Color fundus image, FOV: 45 degrees — 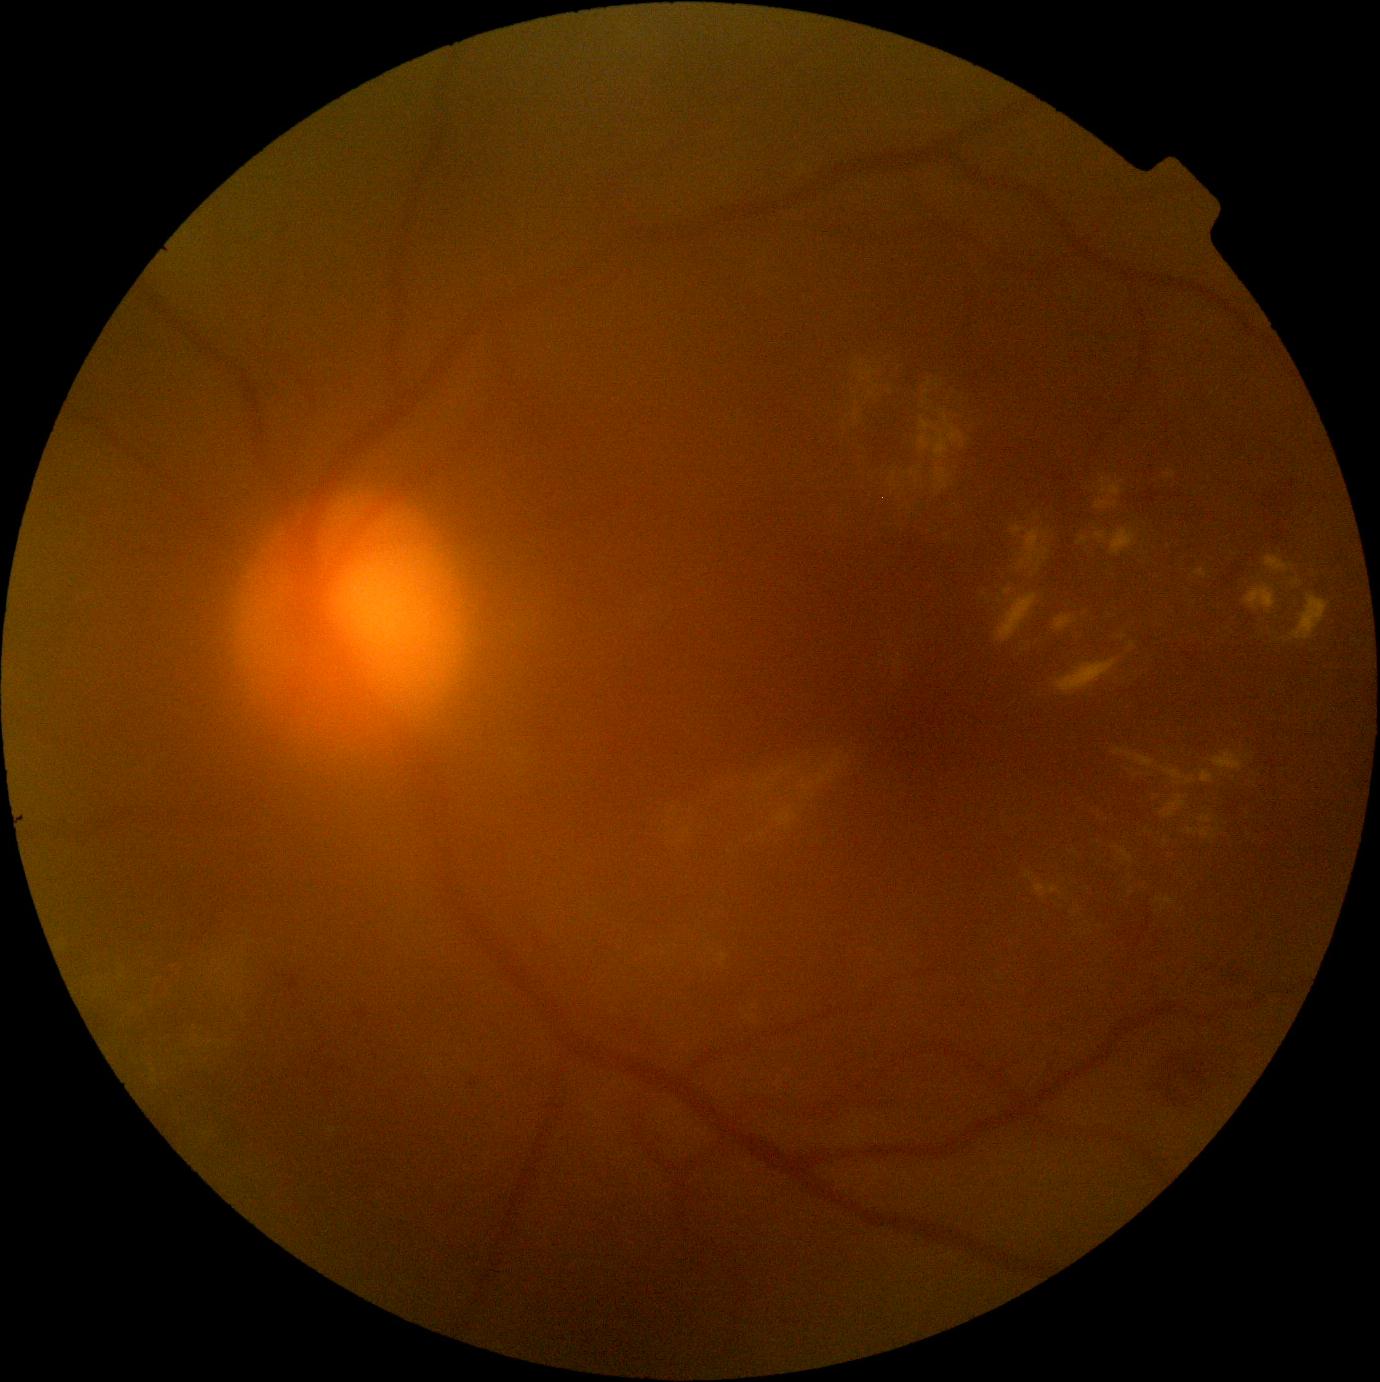 DR grade: 2 (moderate NPDR) — more than just microaneurysms but less than severe NPDR.
The retinopathy is classified as non-proliferative diabetic retinopathy.